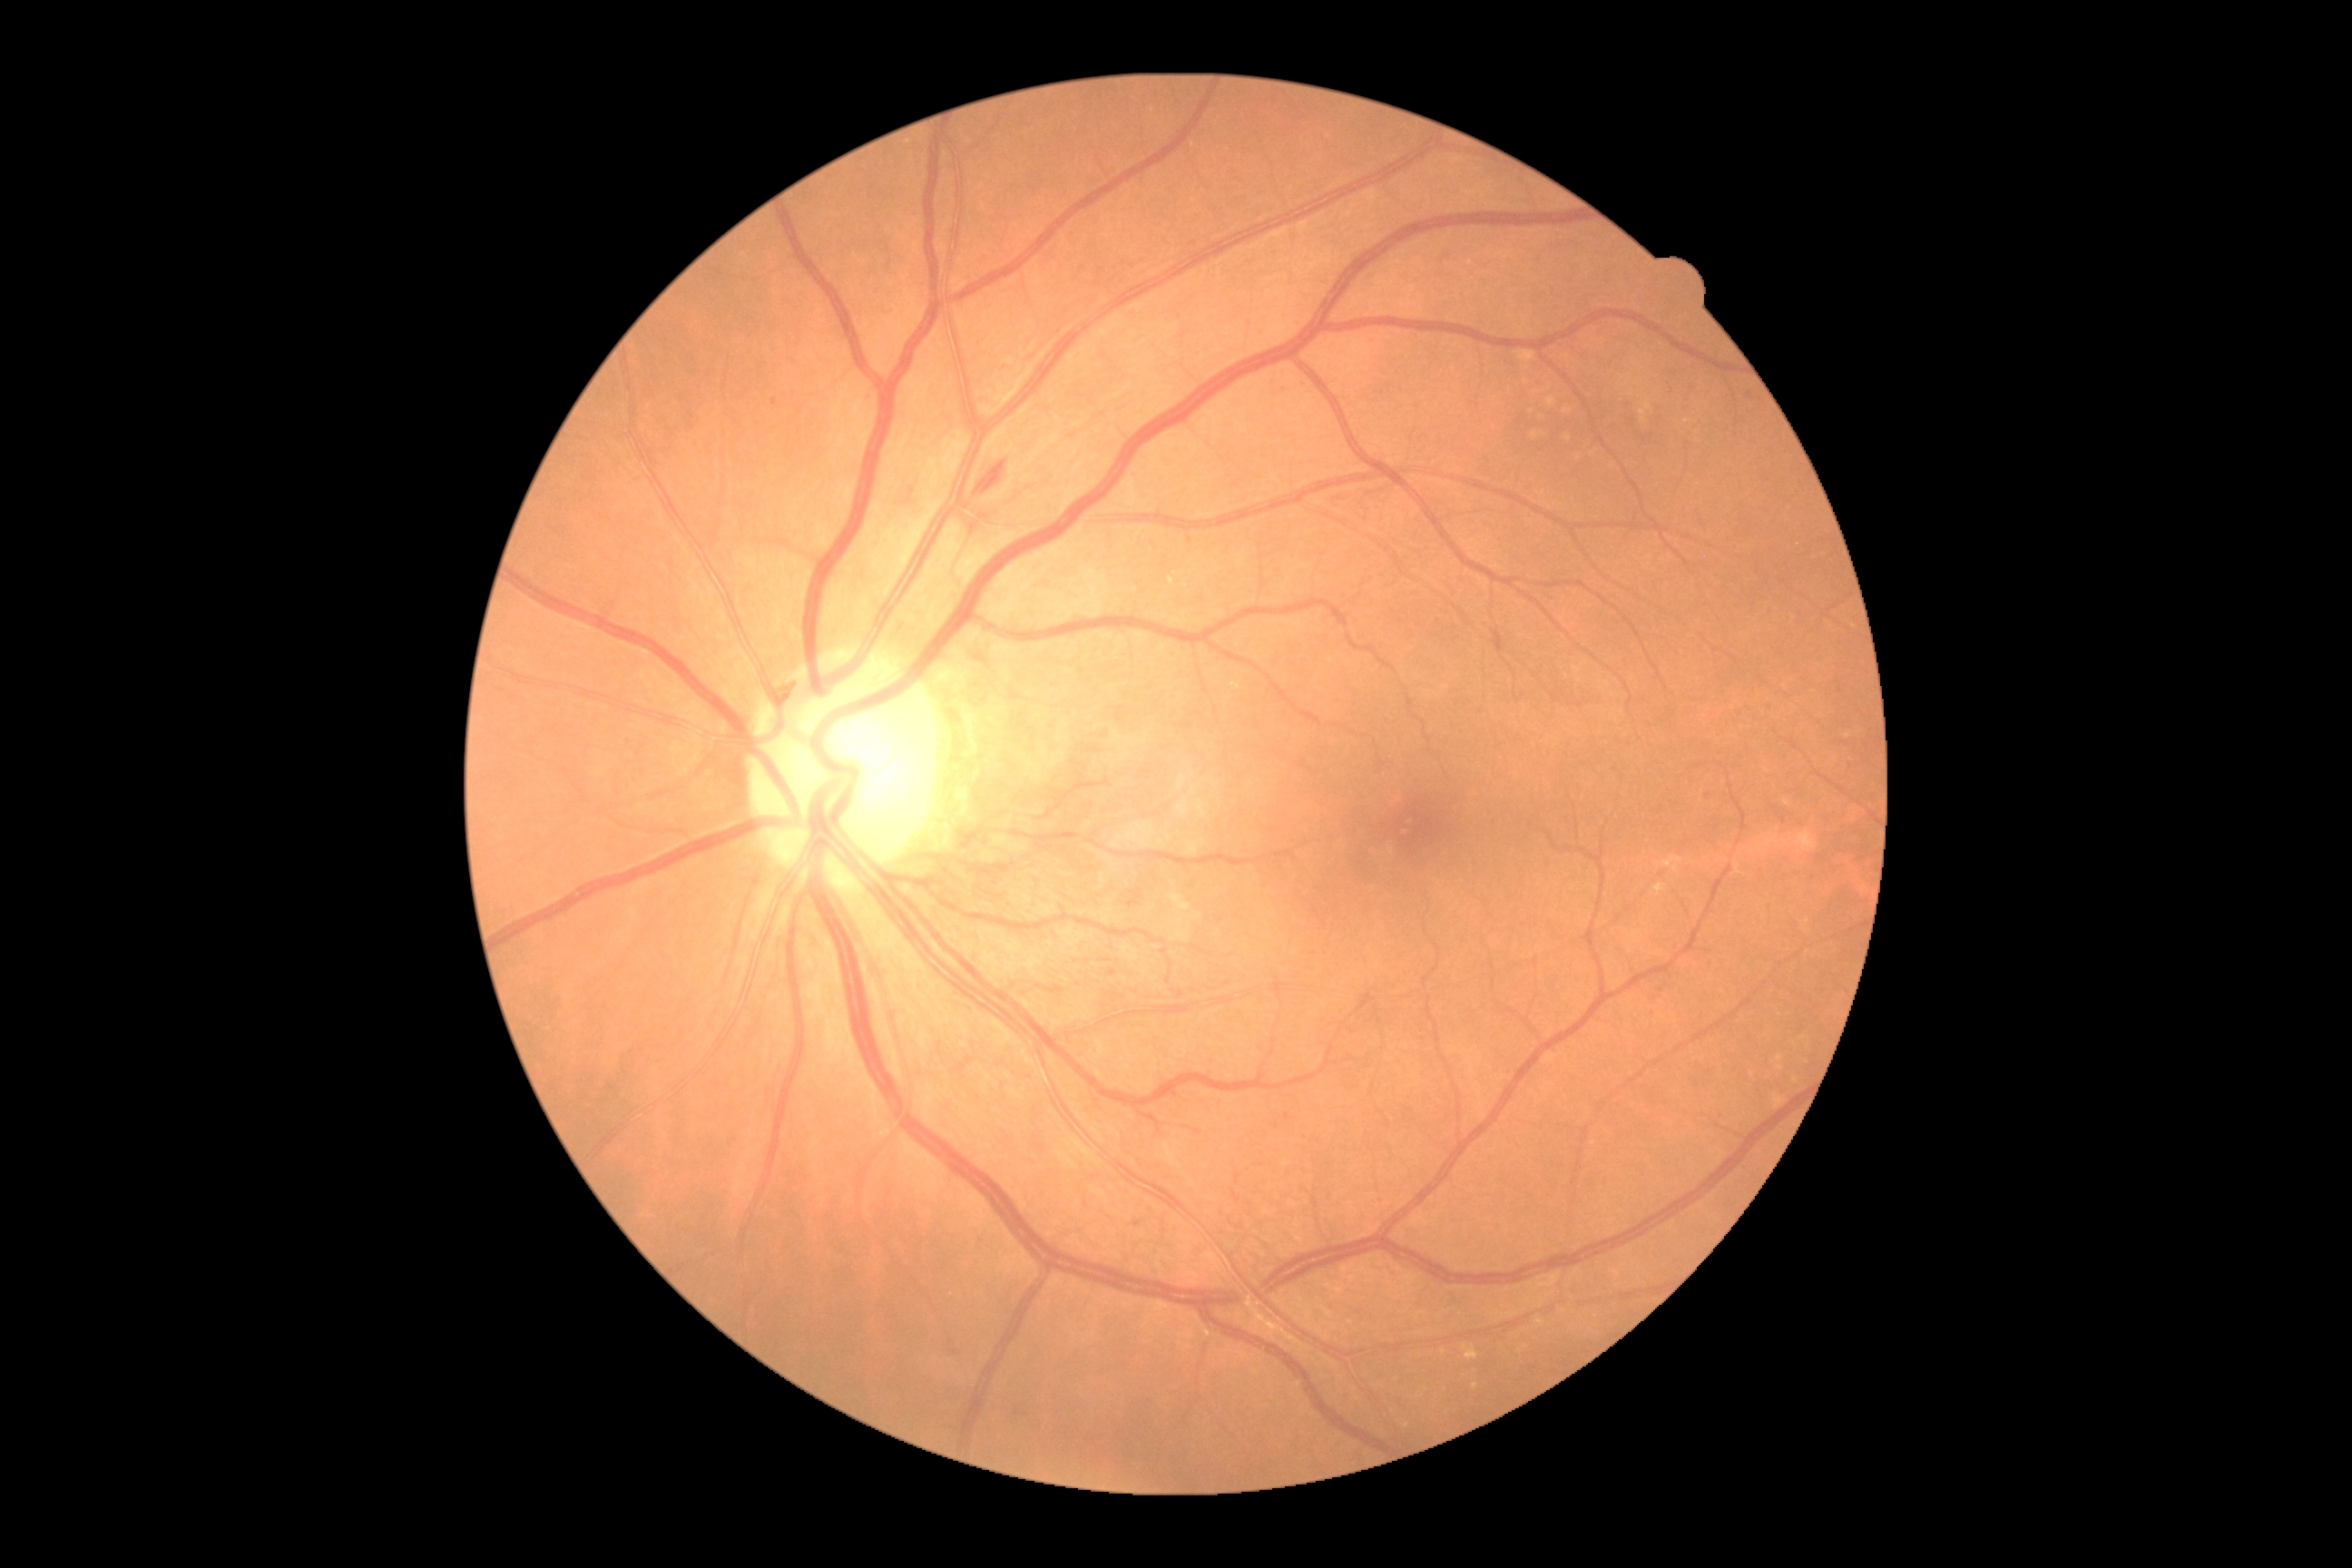
{"dr_grade": 2, "lesions": {"se": null, "ex": [[1654, 885, 1667, 897], [1663, 859, 1669, 867], [1465, 1346, 1480, 1360], [1168, 576, 1175, 585], [1536, 1318, 1545, 1326]], "ex_small_centers": [[1476, 1386]], "ma": [[868, 391, 872, 402]], "ma_small_centers": [[1130, 905], [775, 403], [1113, 972], [1785, 822], [1661, 990], [1706, 795], [1718, 1114]], "he": [[975, 462, 1006, 495]]}}